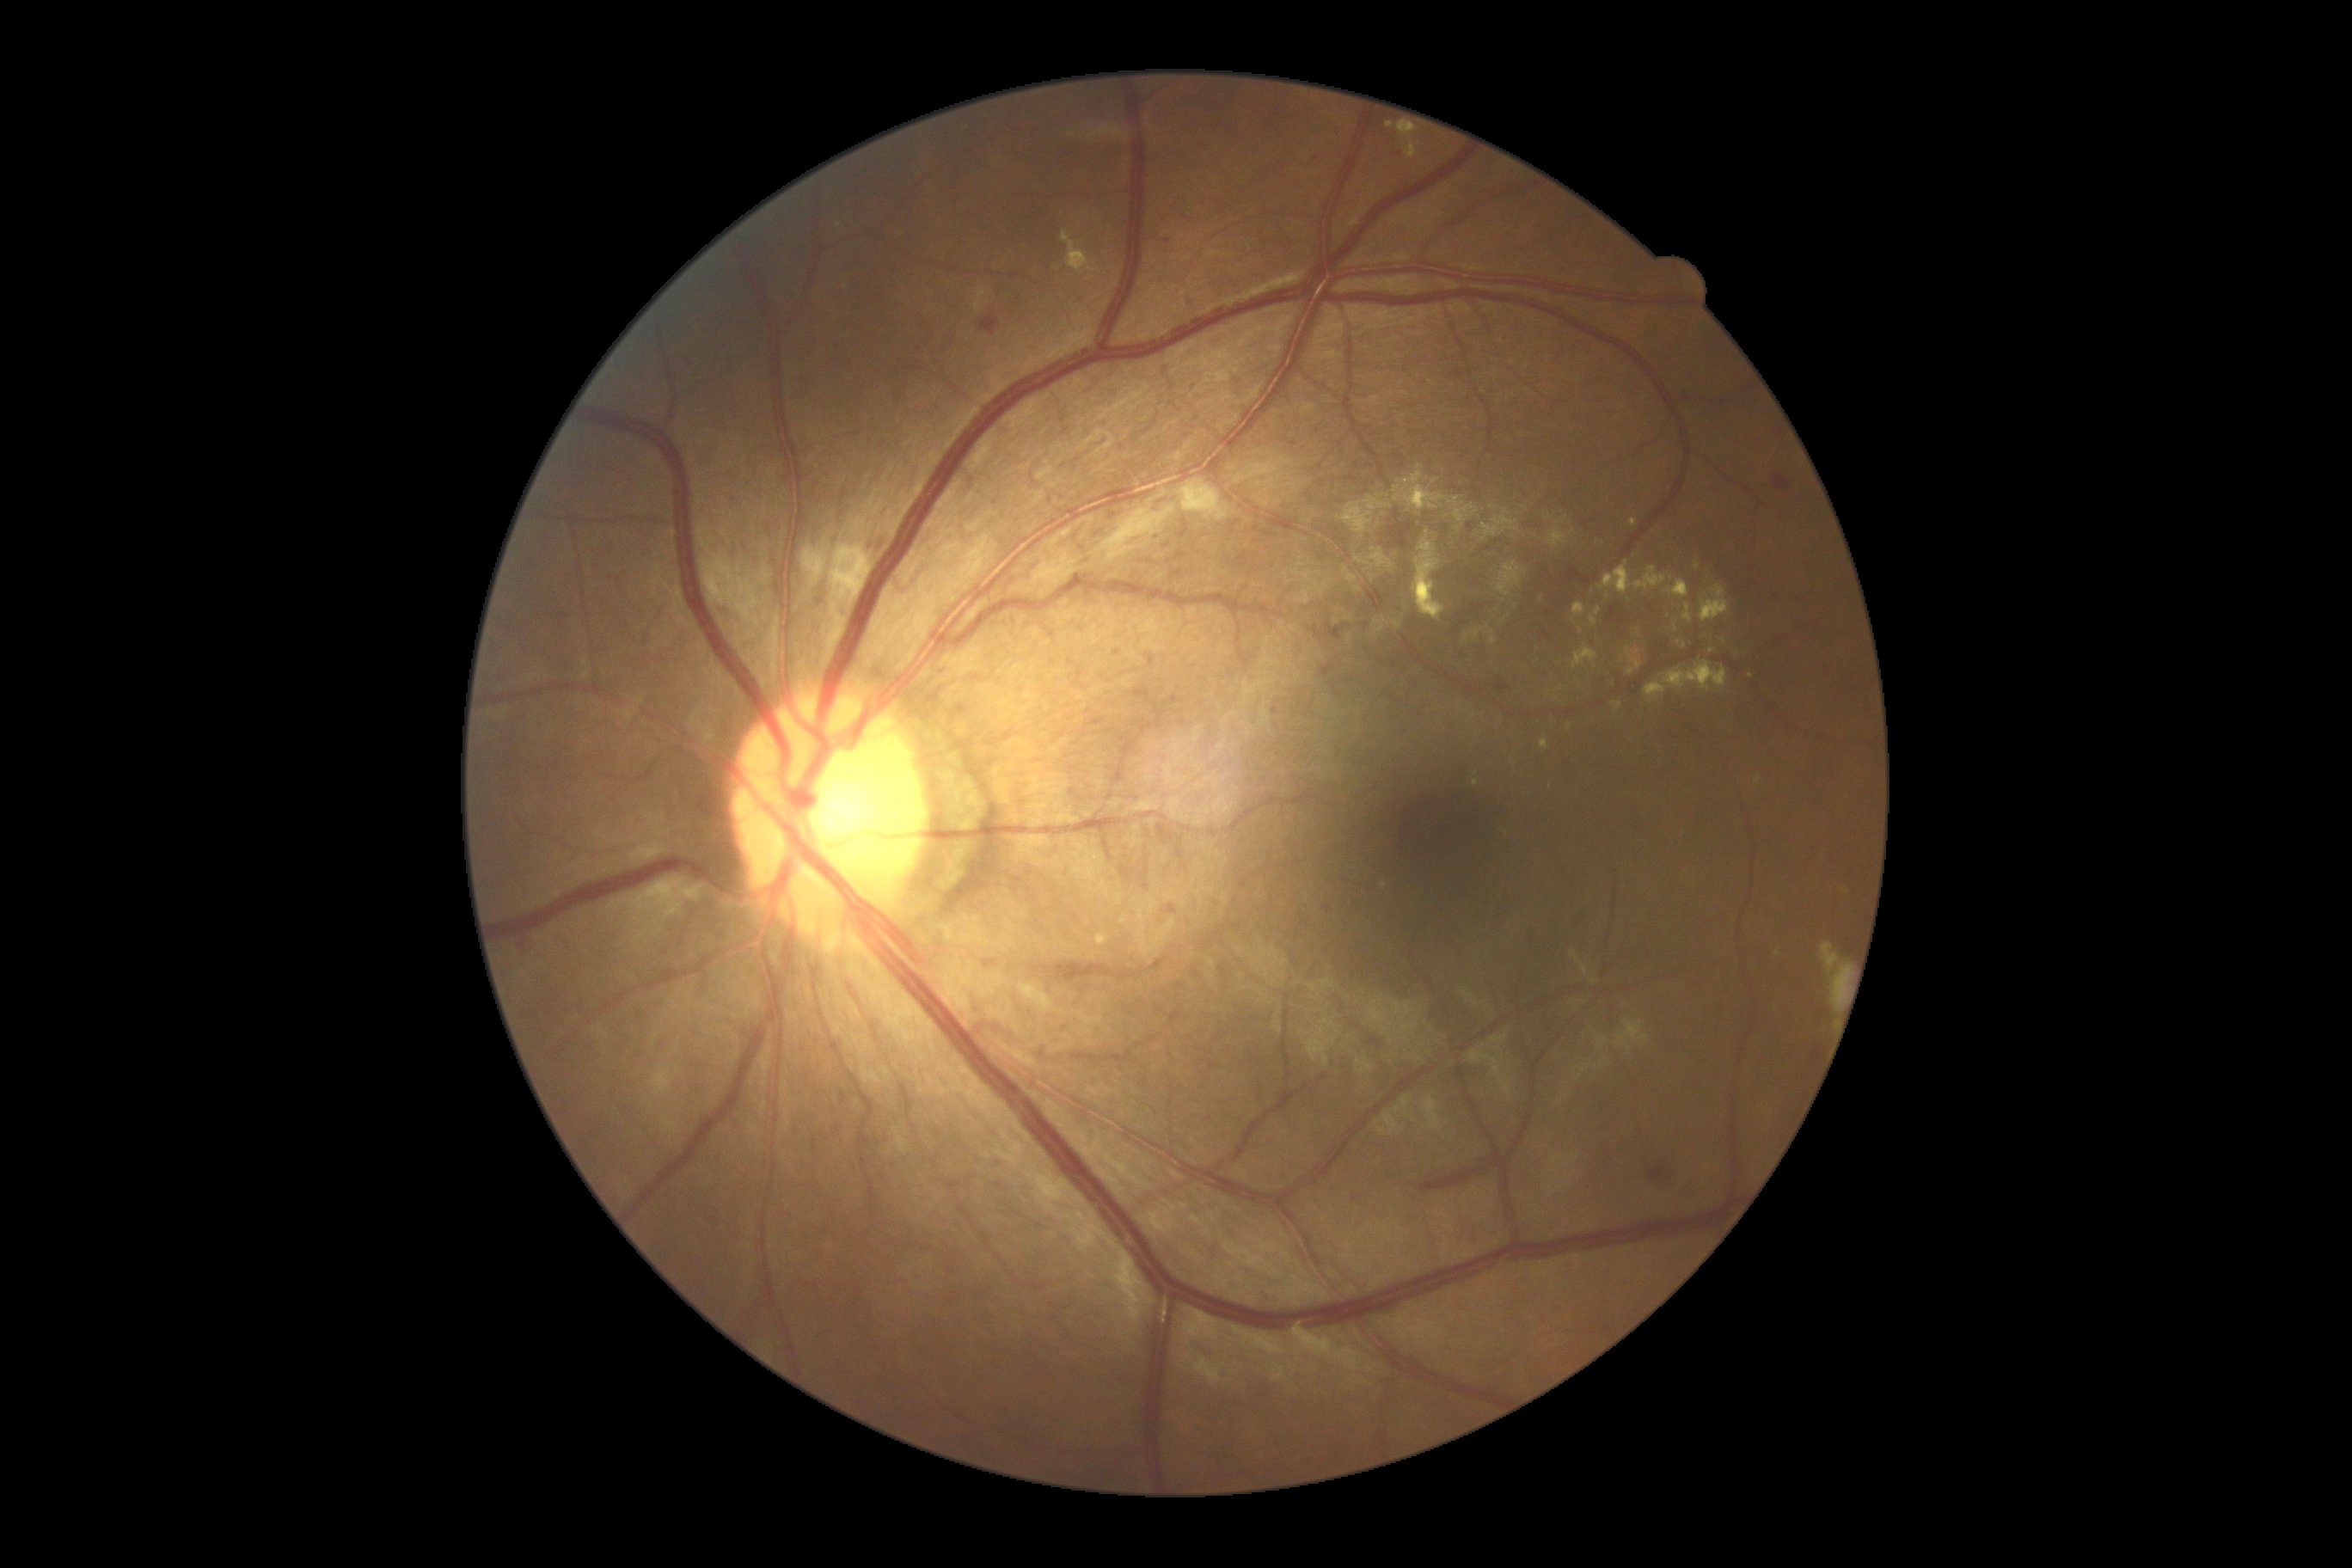
diabetic retinopathy: grade 2 (moderate NPDR) — more than just microaneurysms but less than severe NPDR